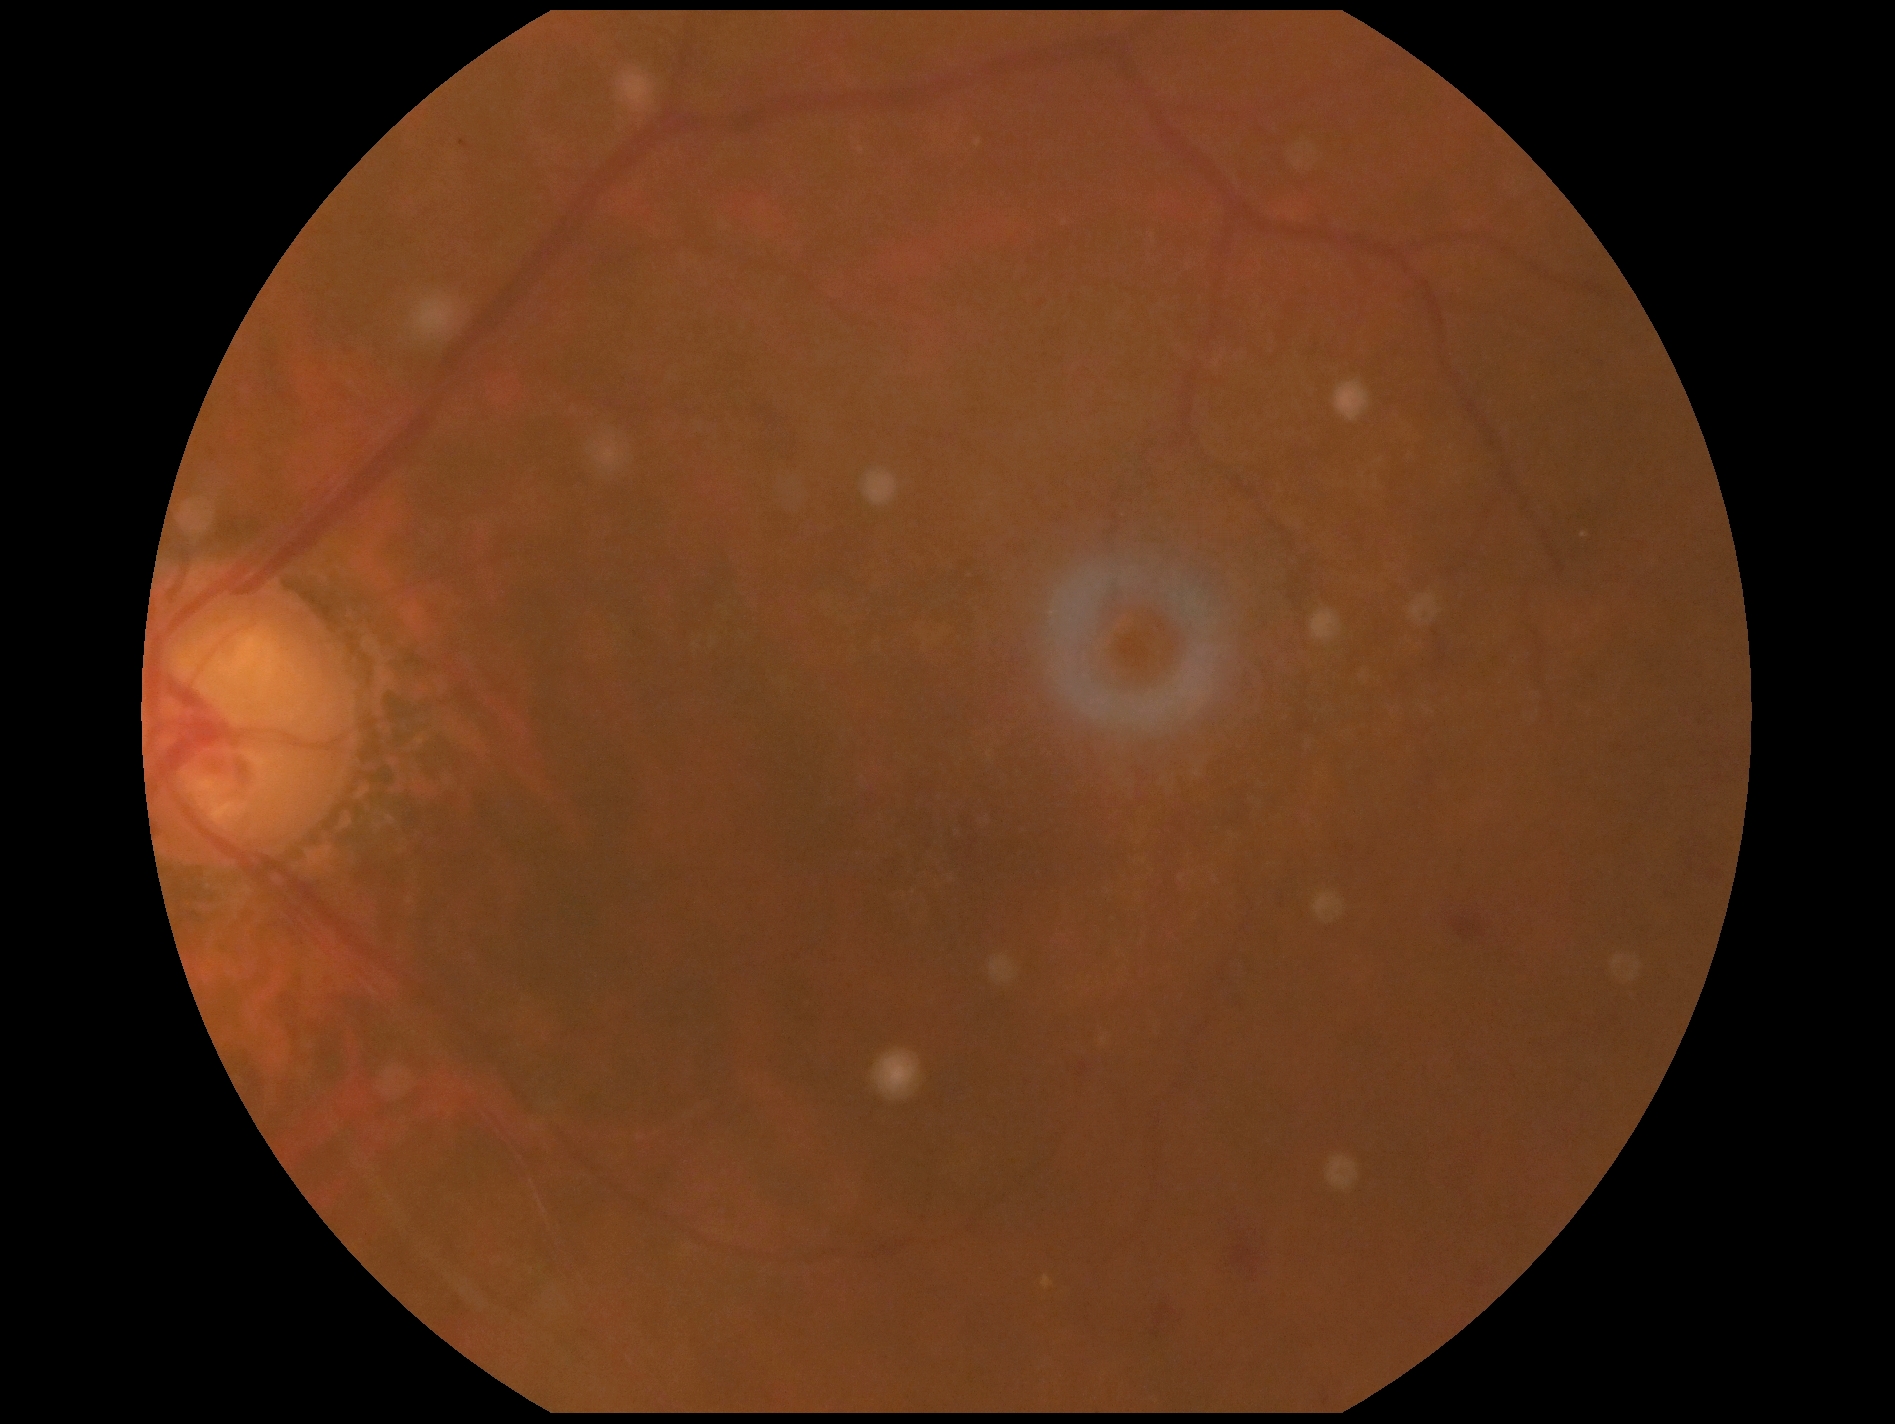

Diabetic retinopathy: 2.